NIDEK AFC-230 fundus camera; 848 x 848 pixels; 45° FOV — 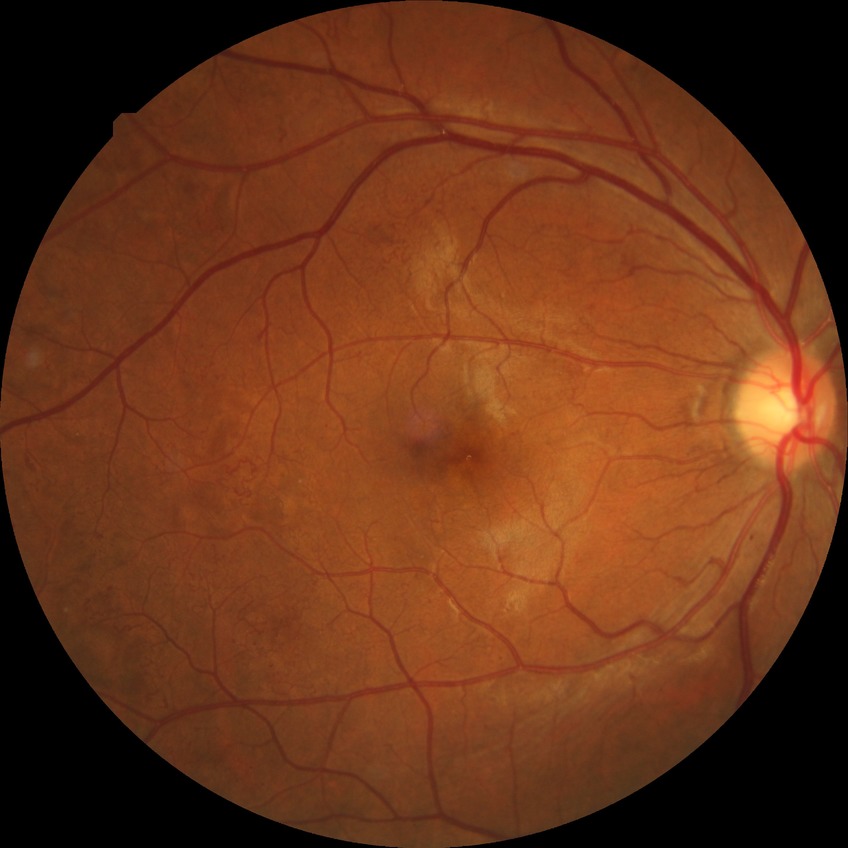 diabetic retinopathy (DR): PDR (proliferative diabetic retinopathy).